CFP.
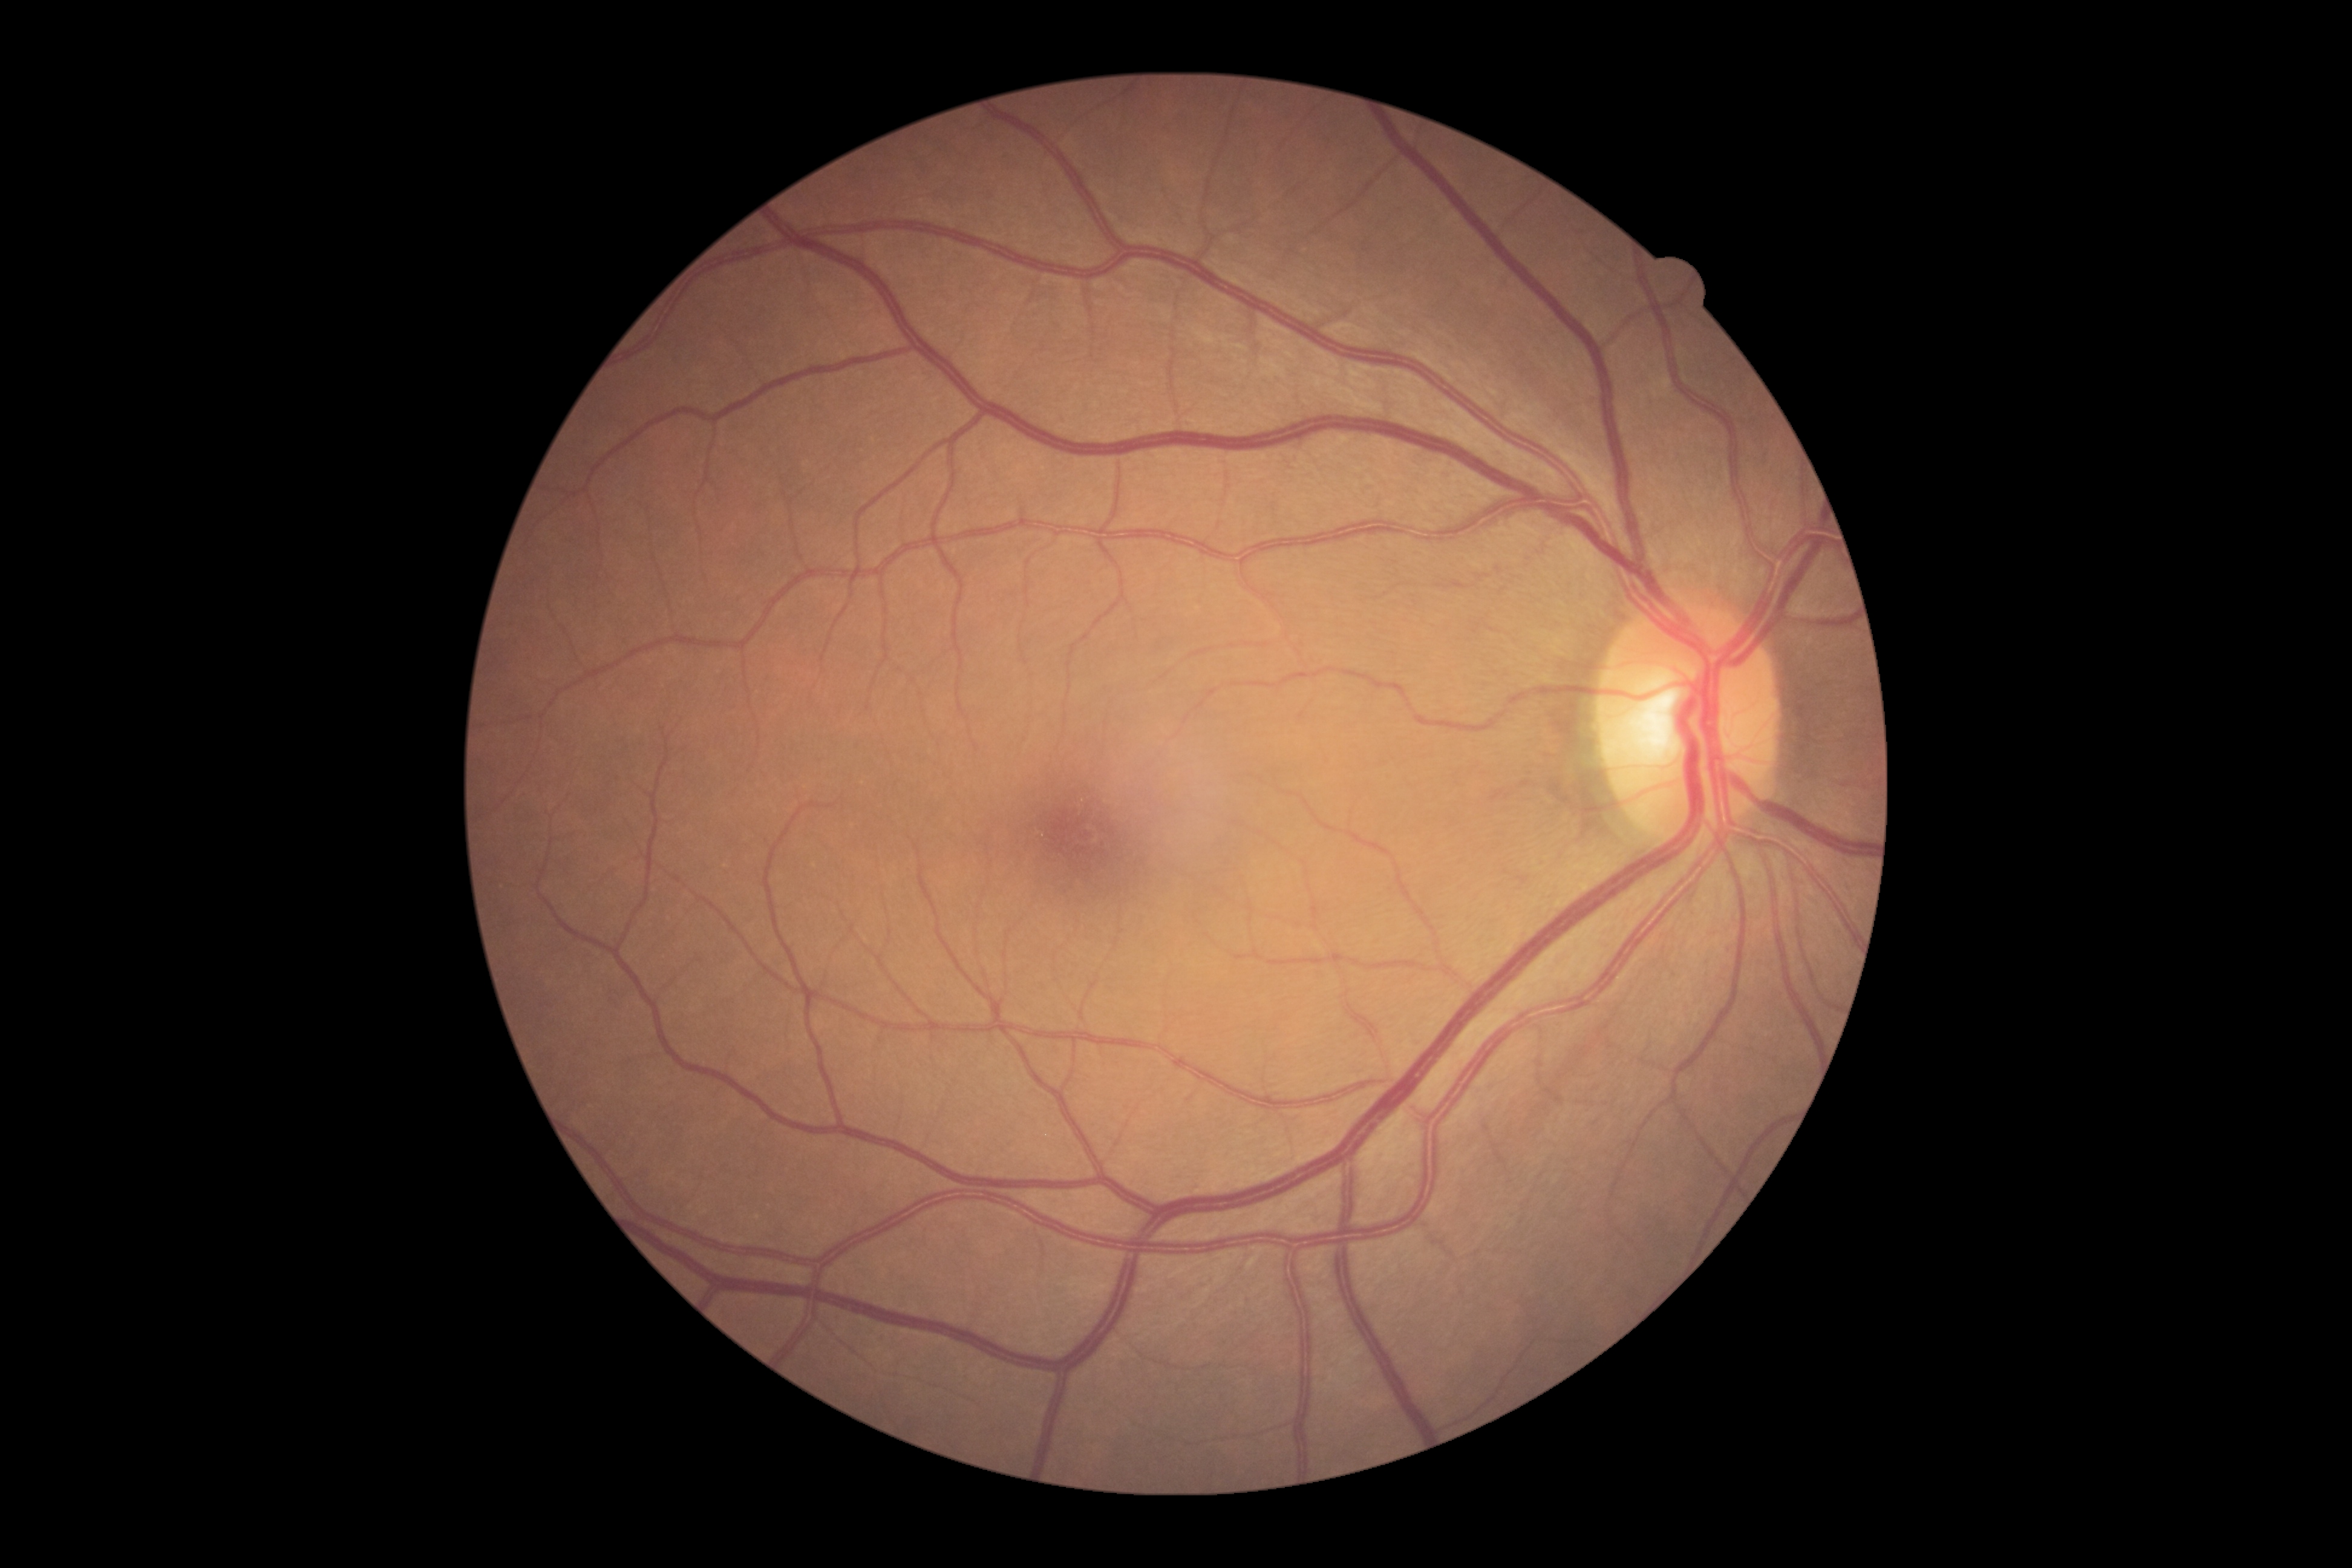 {"dr_grade": "0/4", "dr_impression": "no apparent DR"}